1240x1240px · wide-field fundus photograph of an infant.
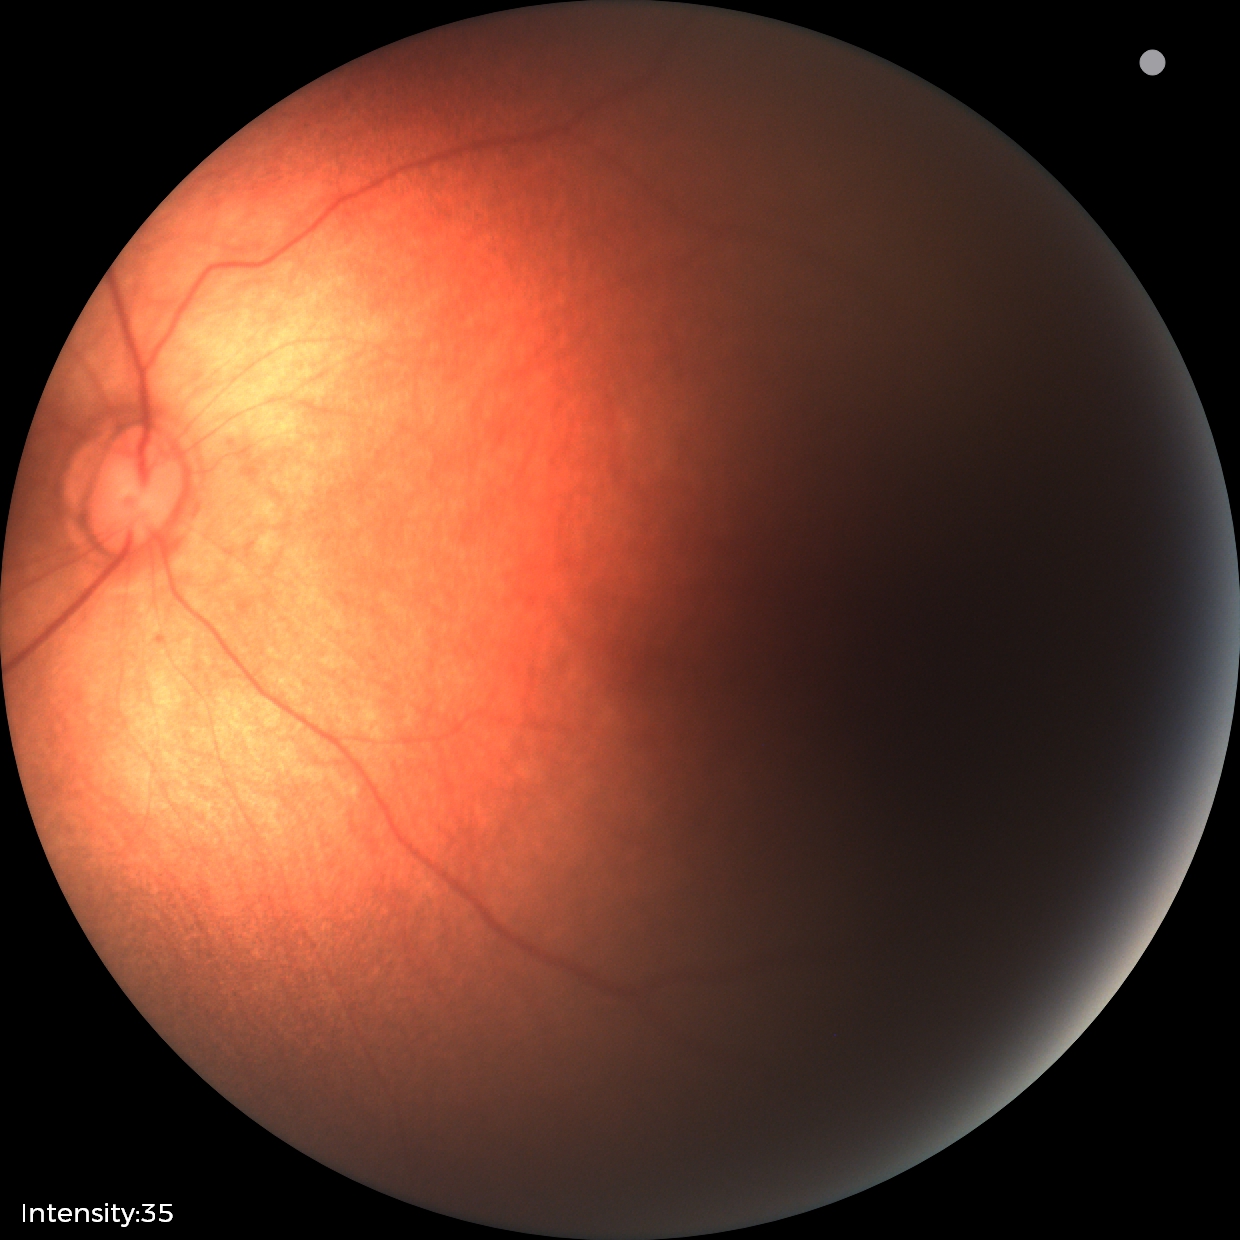
Examination with physiological retinal findings.